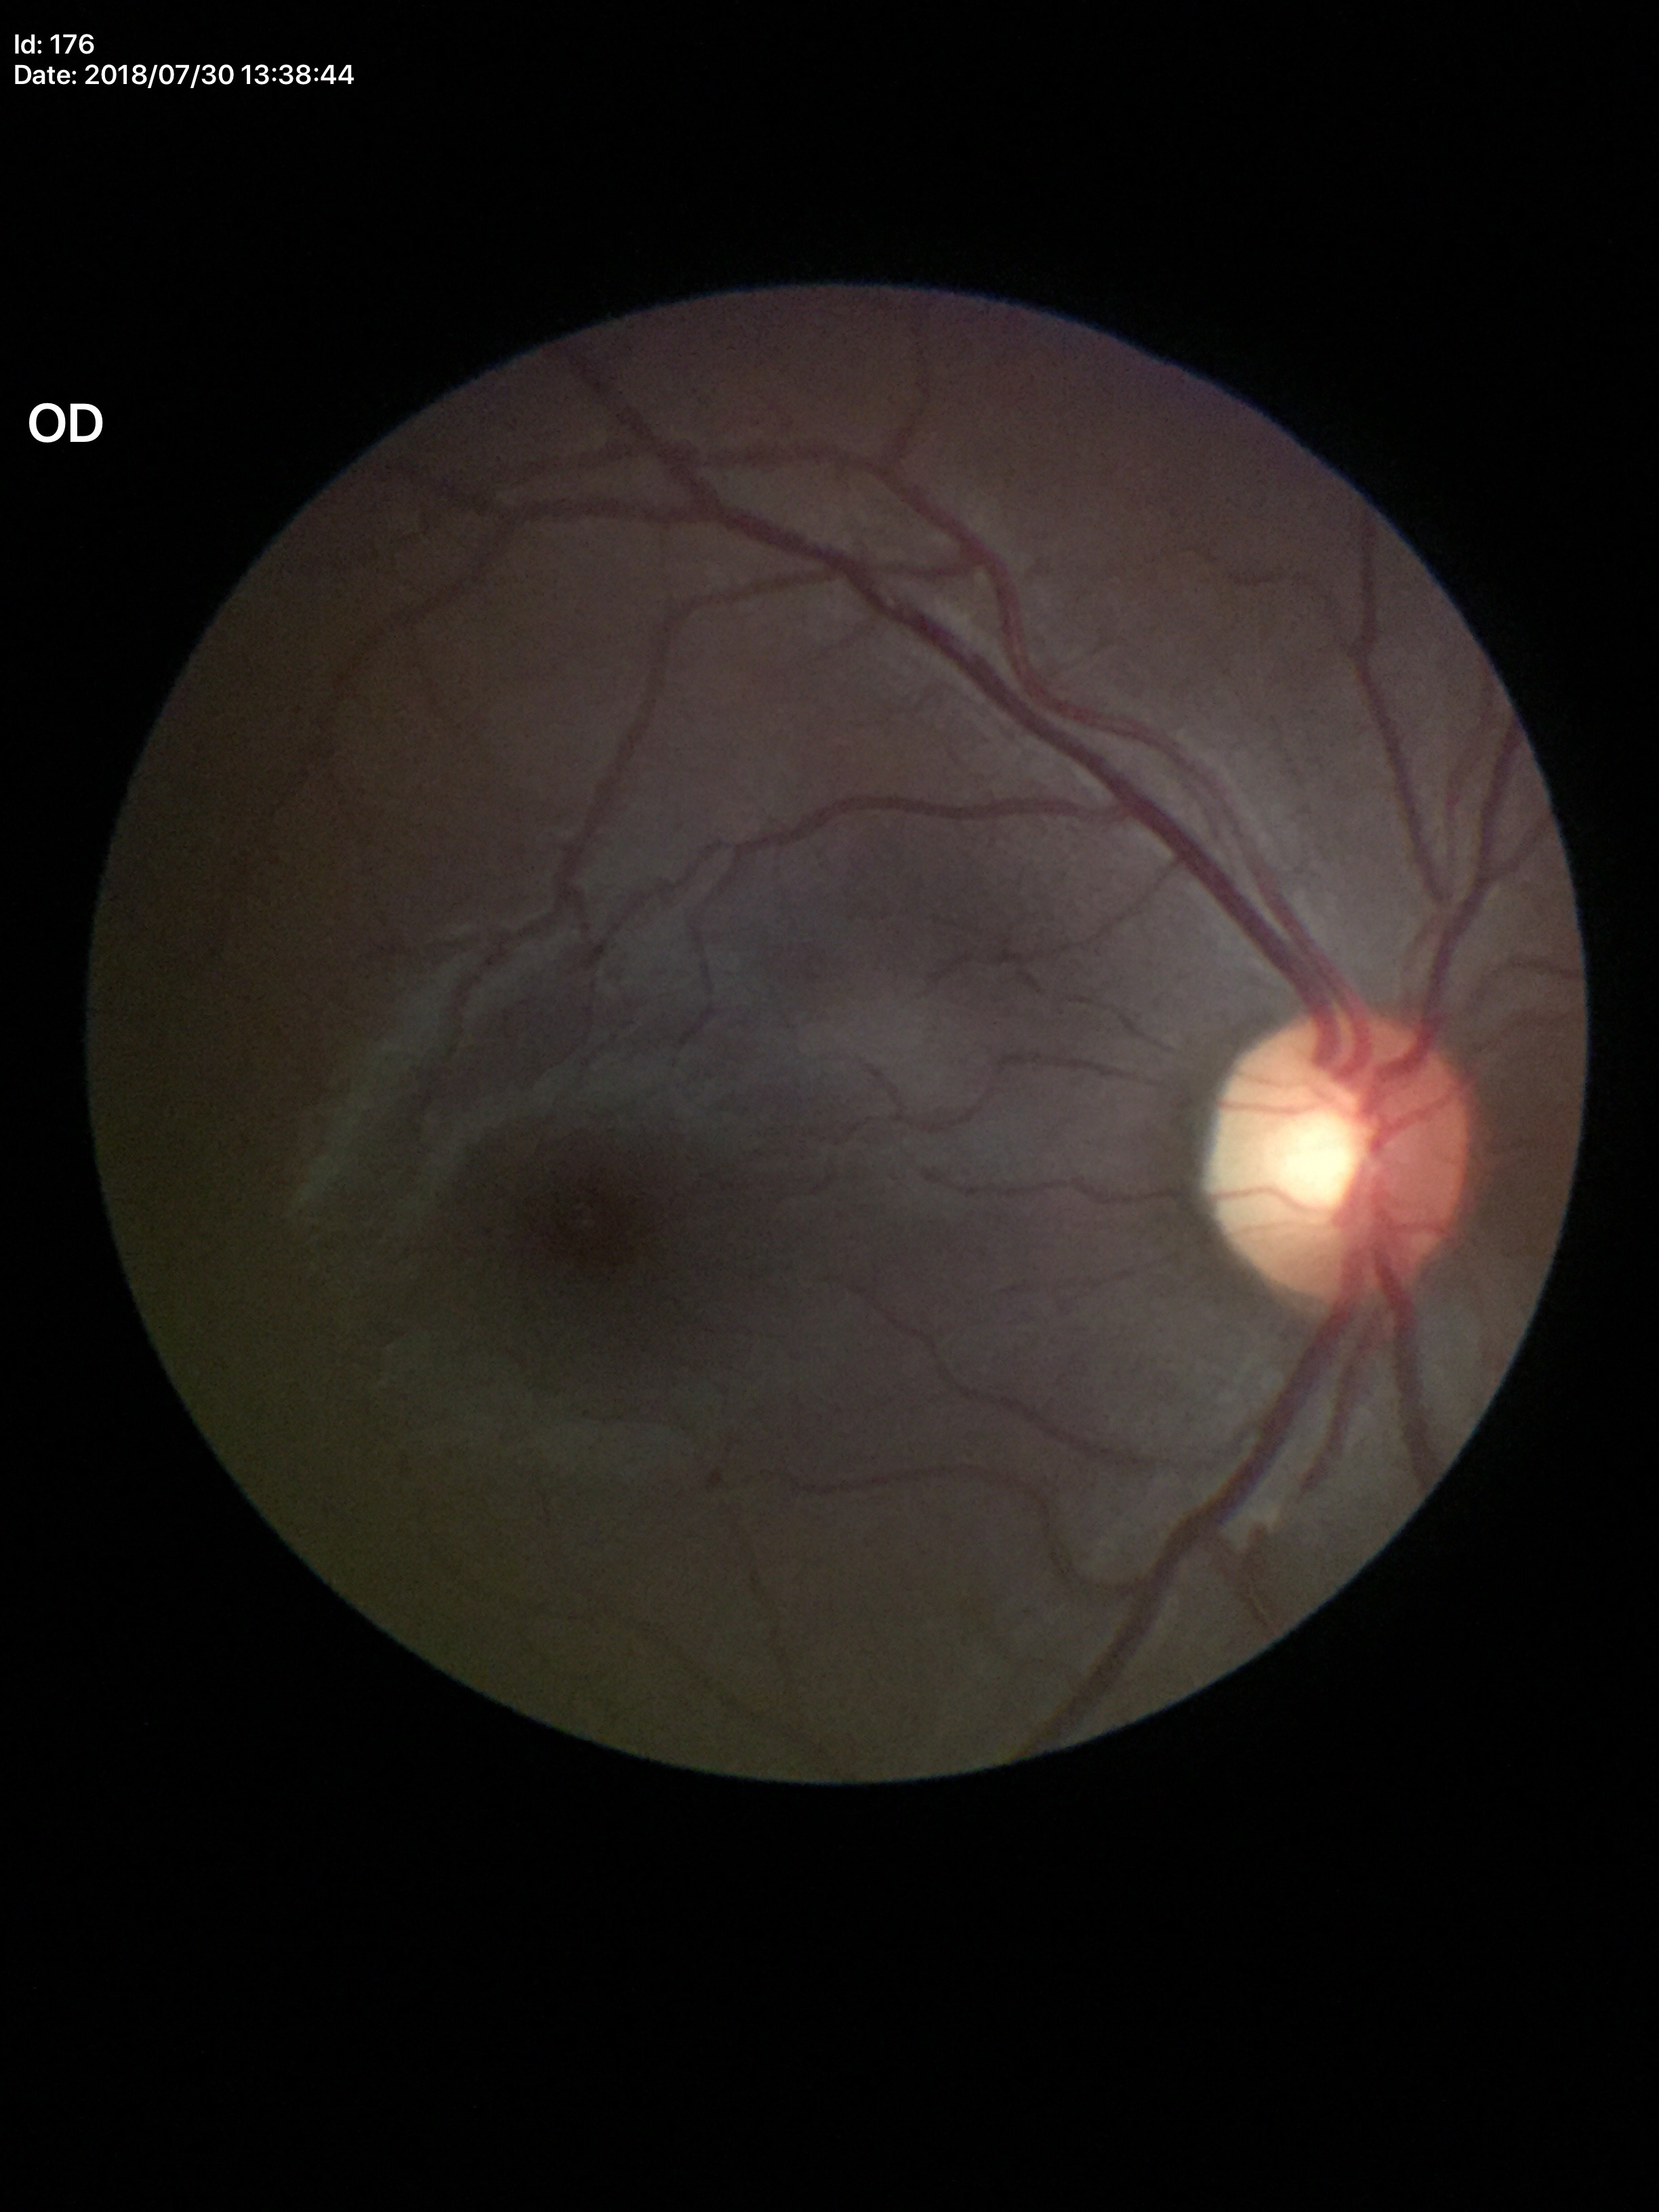 No glaucomatous optic neuropathy. Area C/D ratio is 0.28. Vertical cup-to-disc ratio: 0.56.